Nidek AFC-330: 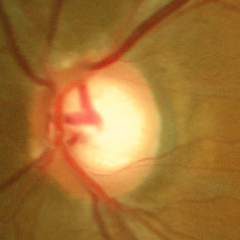

Glaucoma status = no evidence of glaucoma.